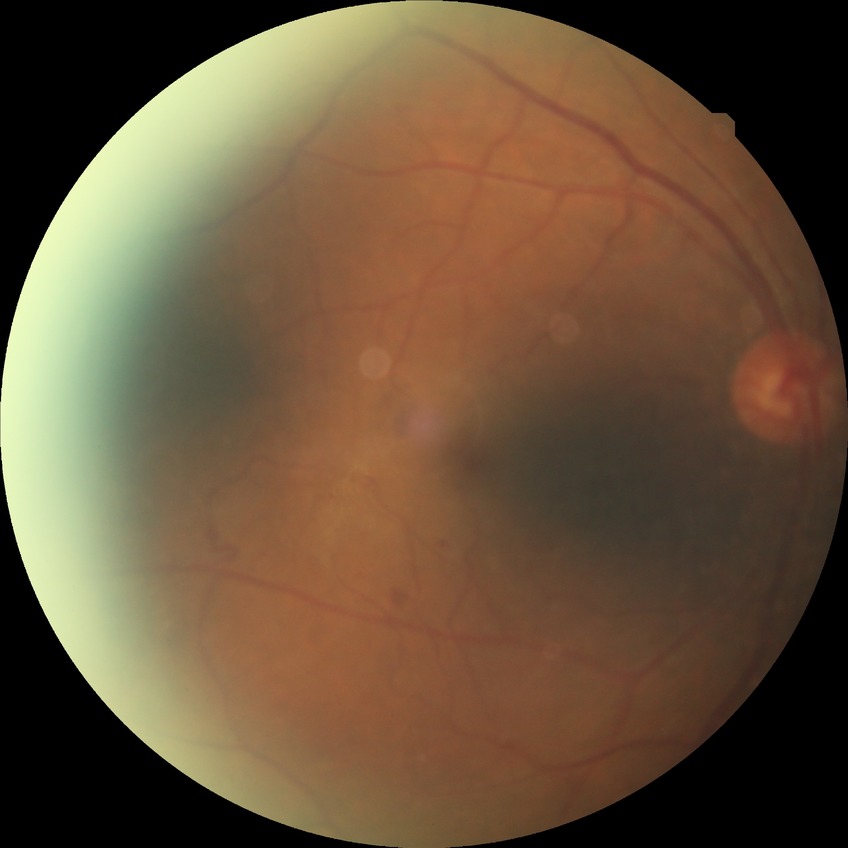
diabetic retinopathy (DR): proliferative diabetic retinopathy (PDR).